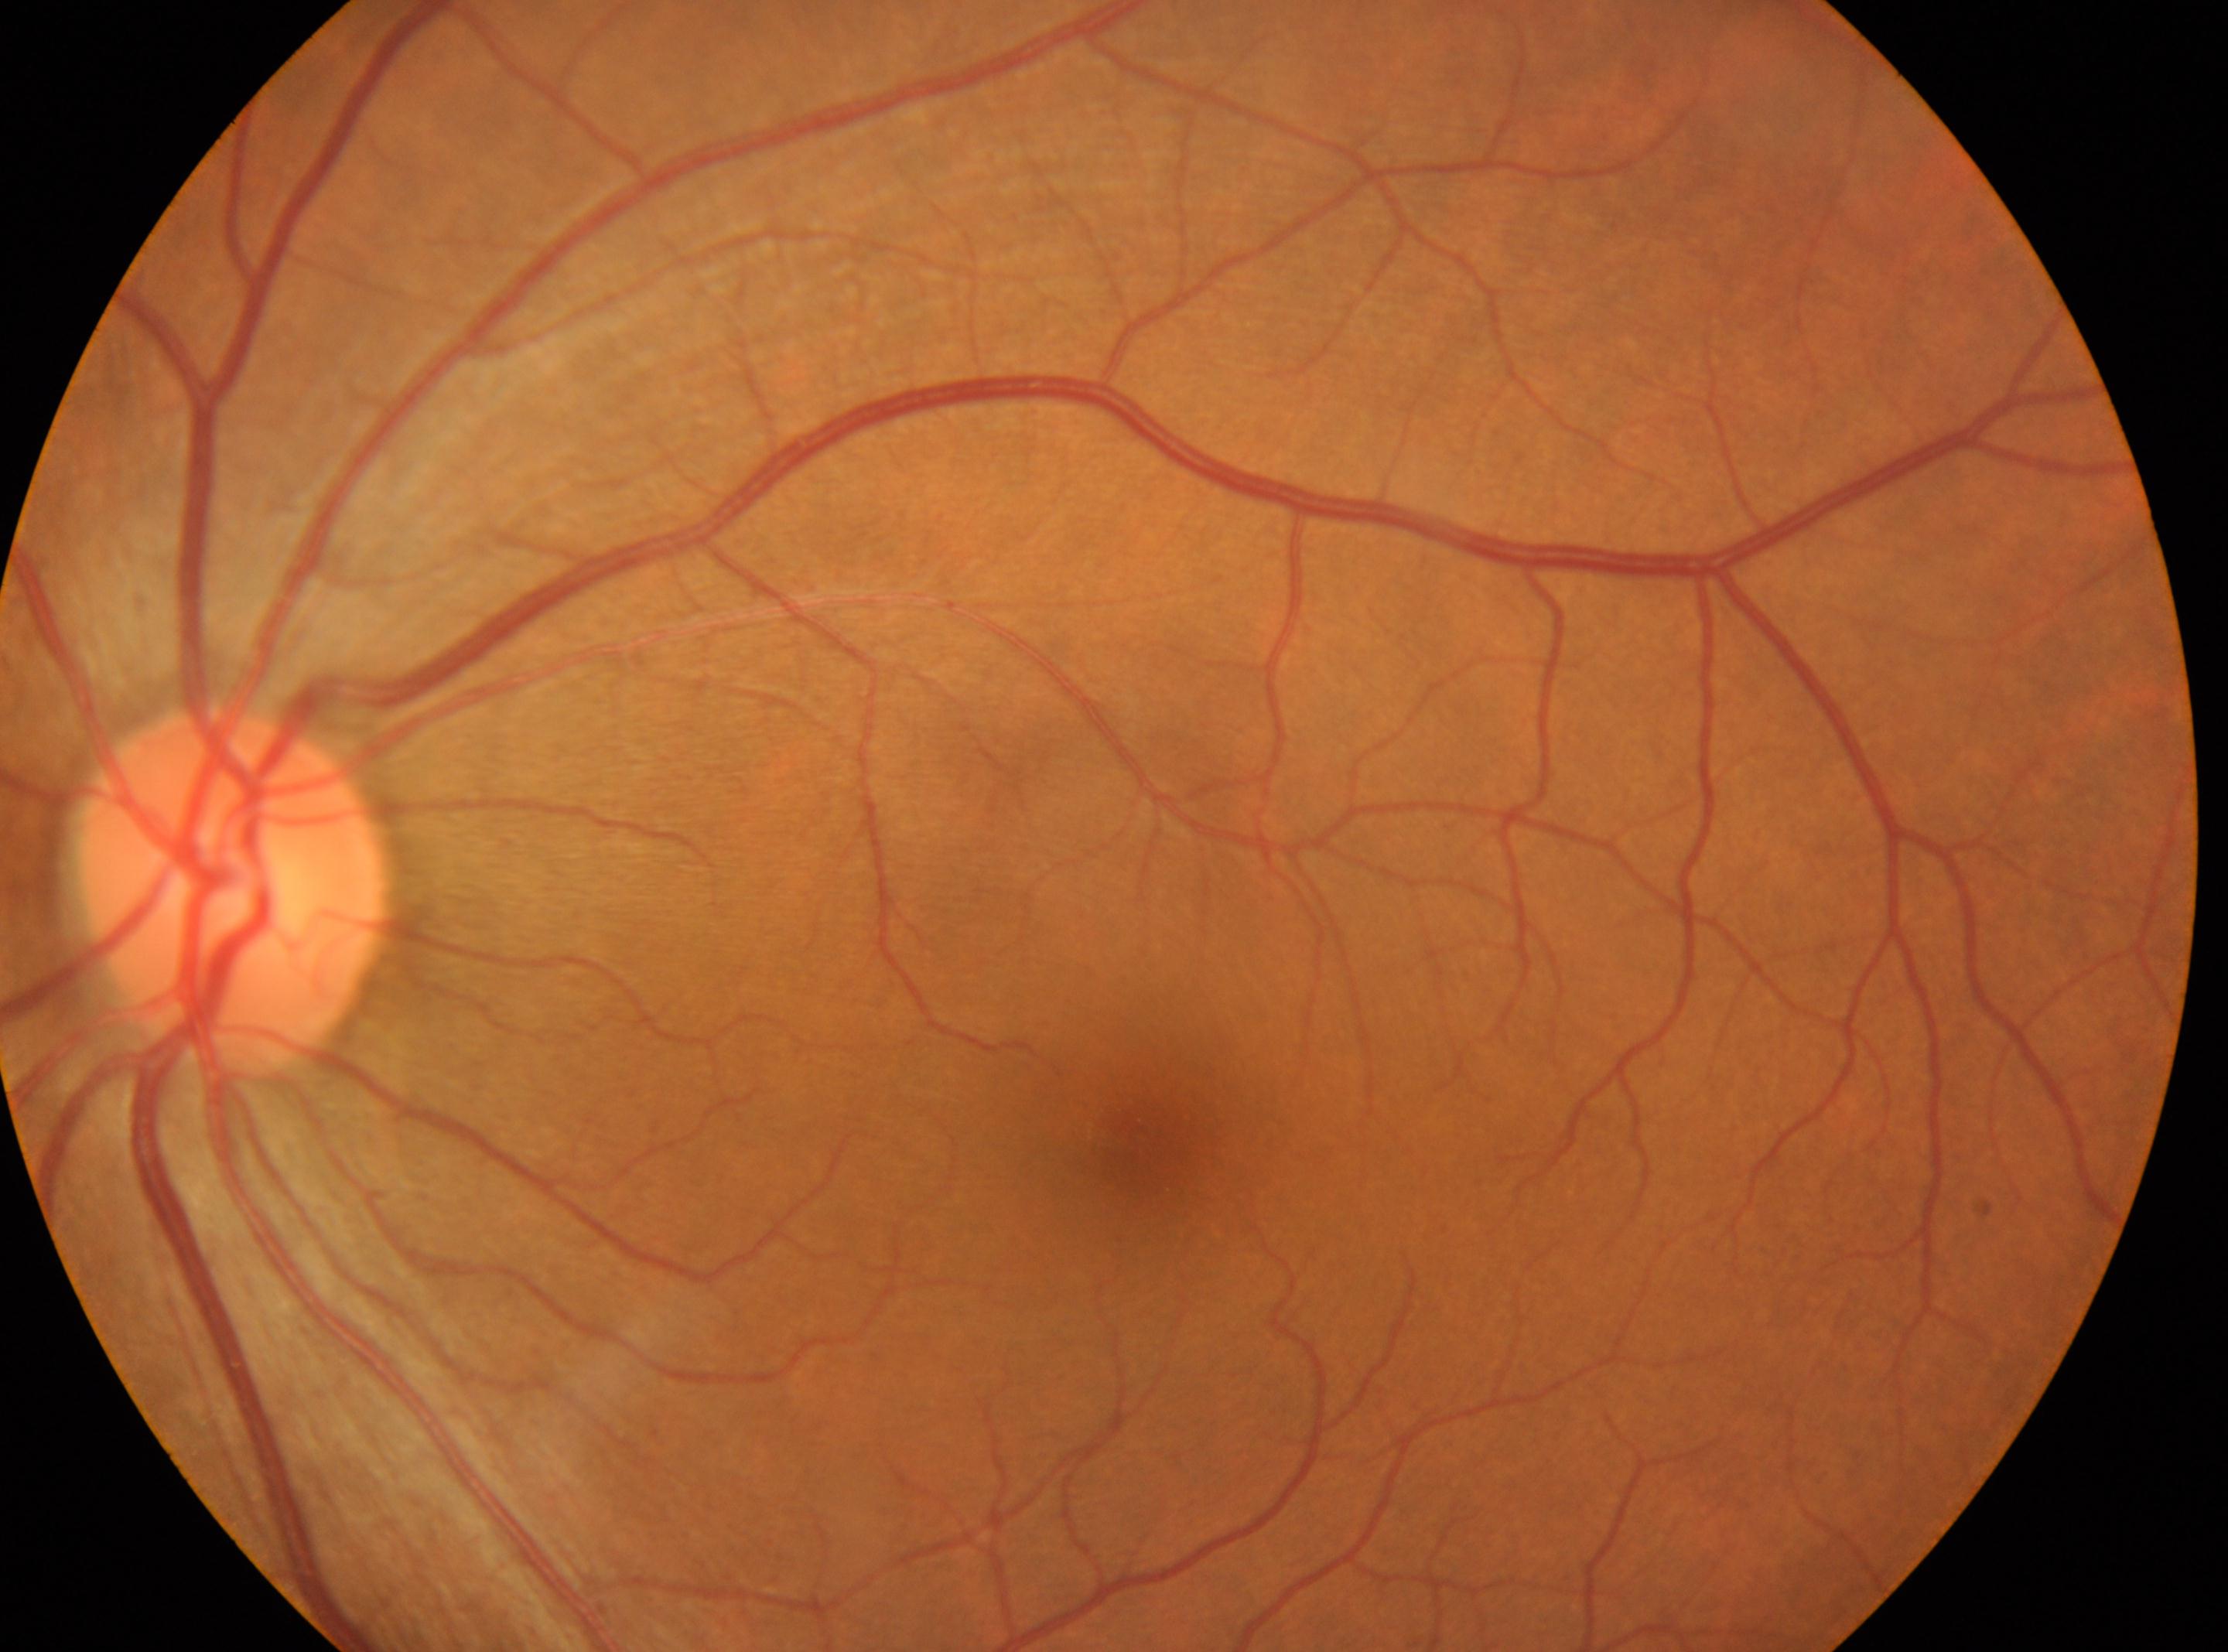

This is the OS. The macula center is at (1140, 1132). DR stage: no apparent diabetic retinopathy (grade 0). Optic disc located at (233, 889).